45° FOV — 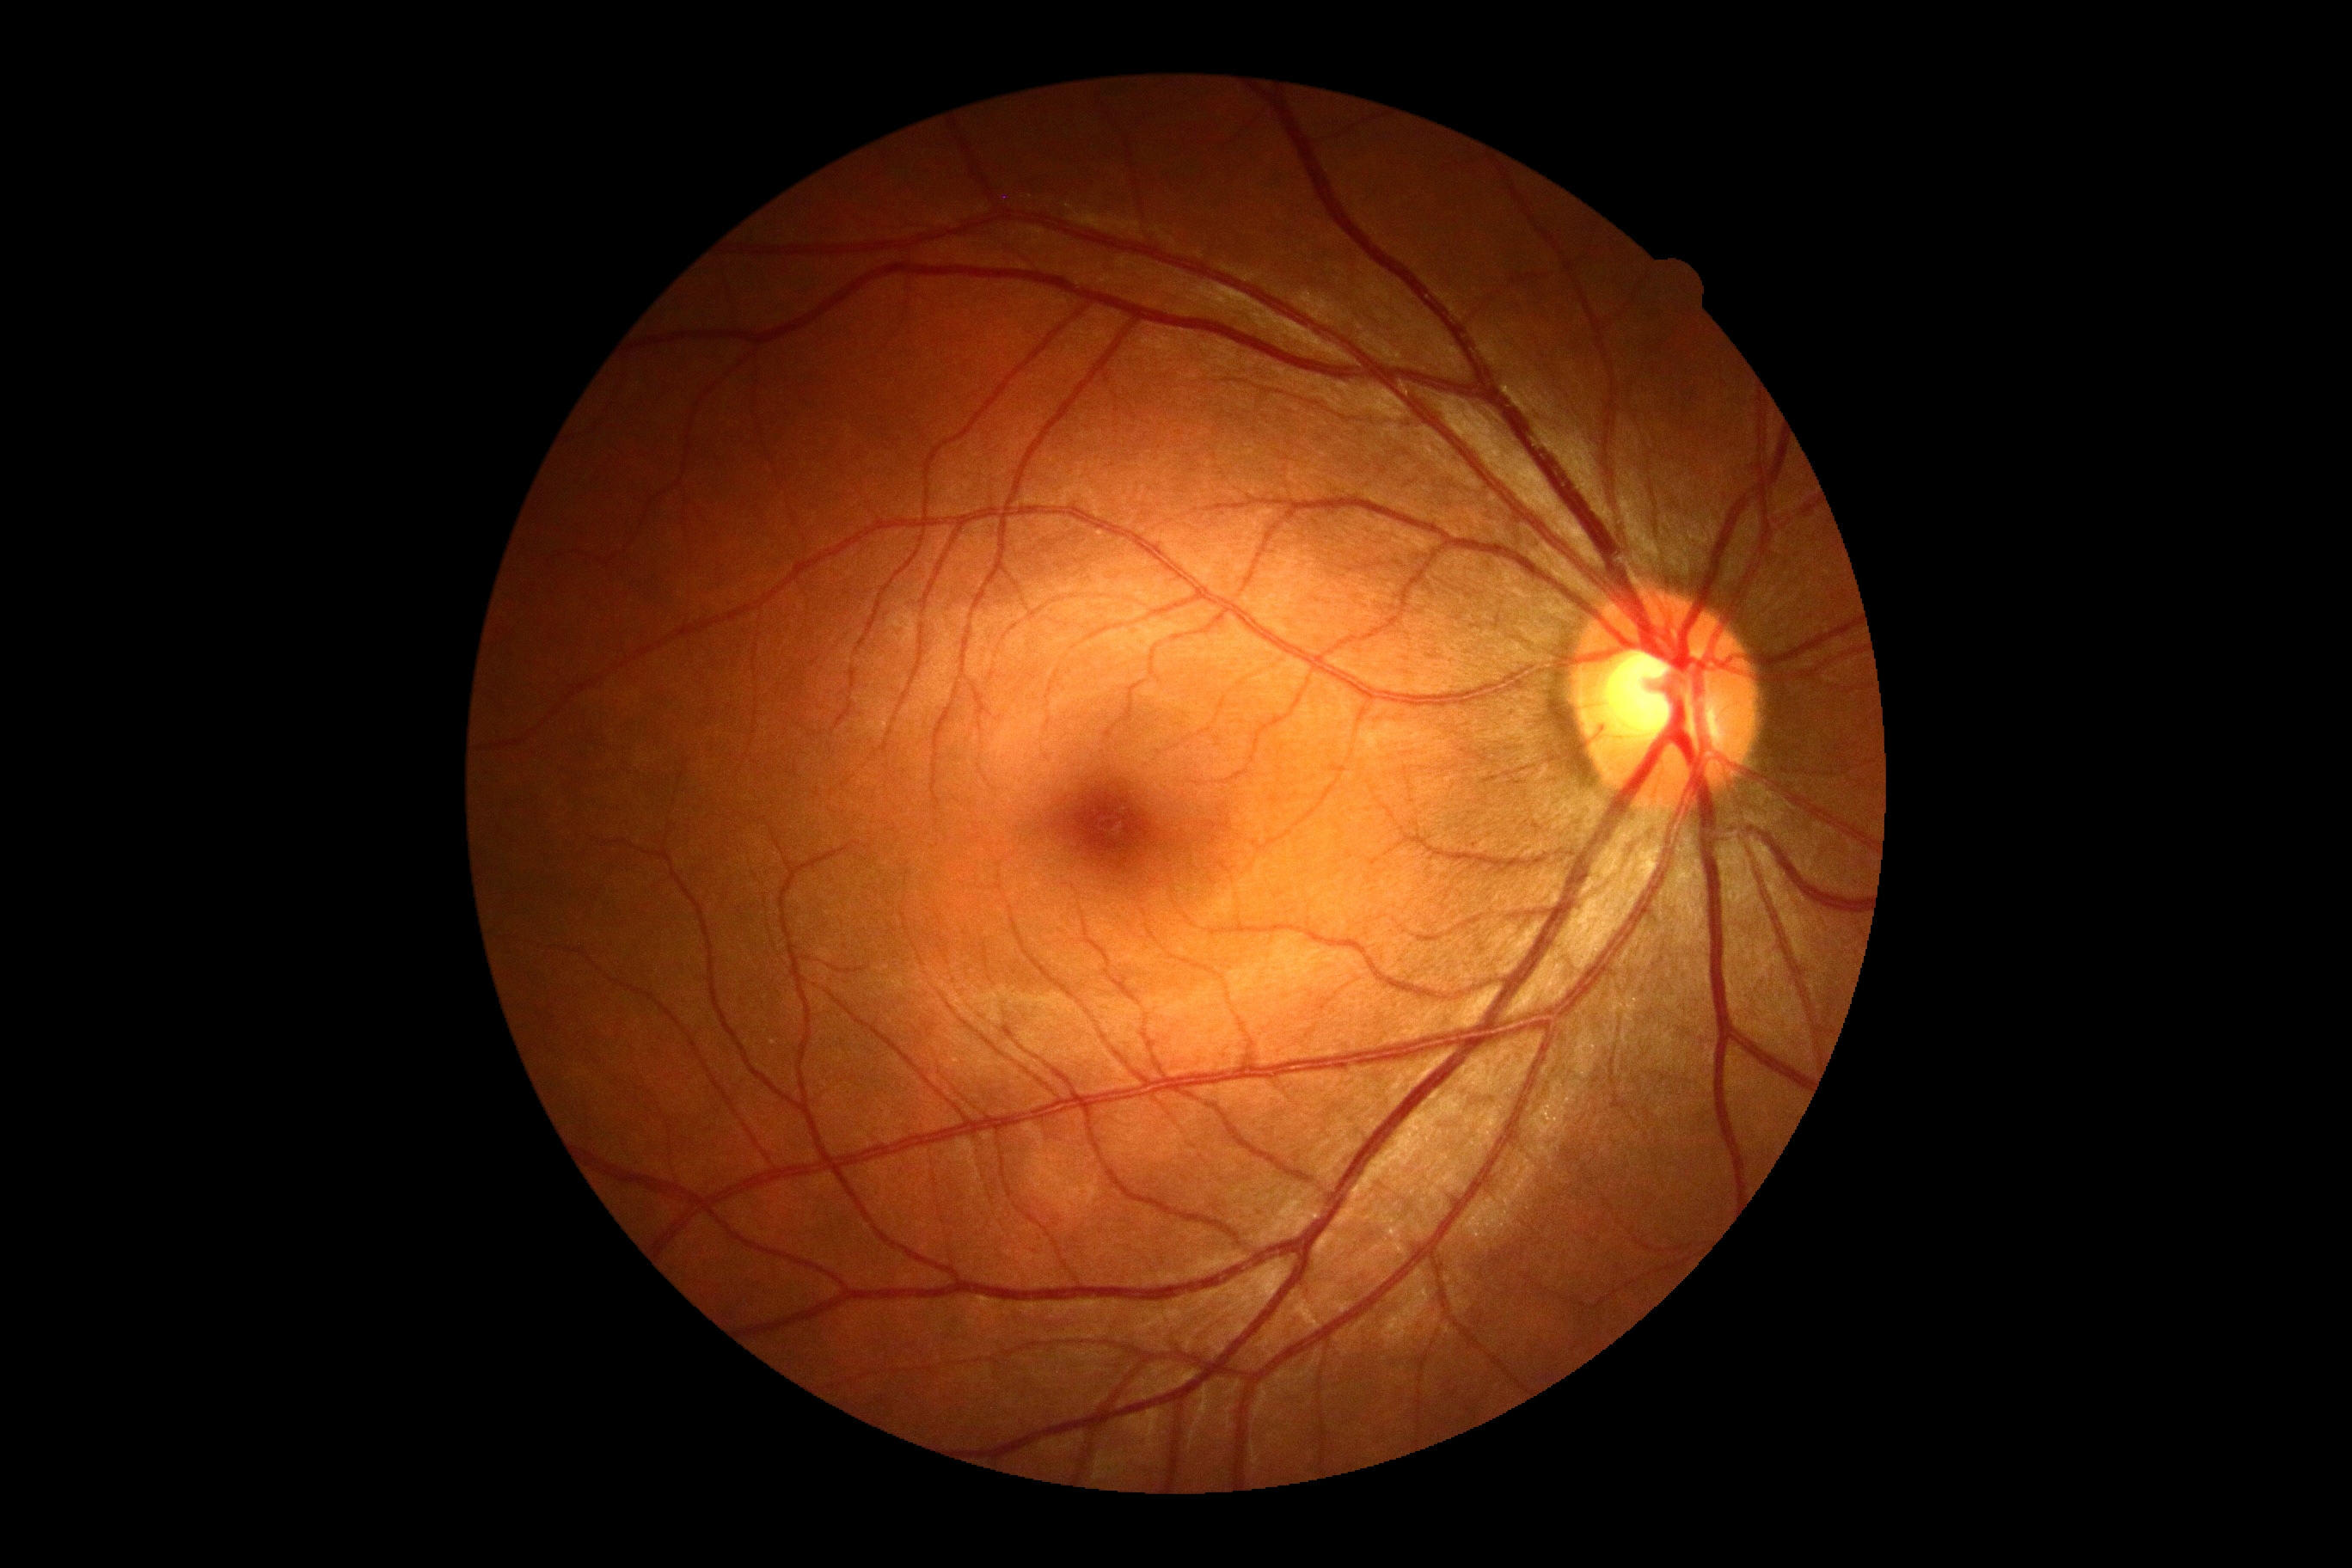 Retinopathy is grade 0 (no apparent retinopathy).